45-degree field of view. 2352x1568 — 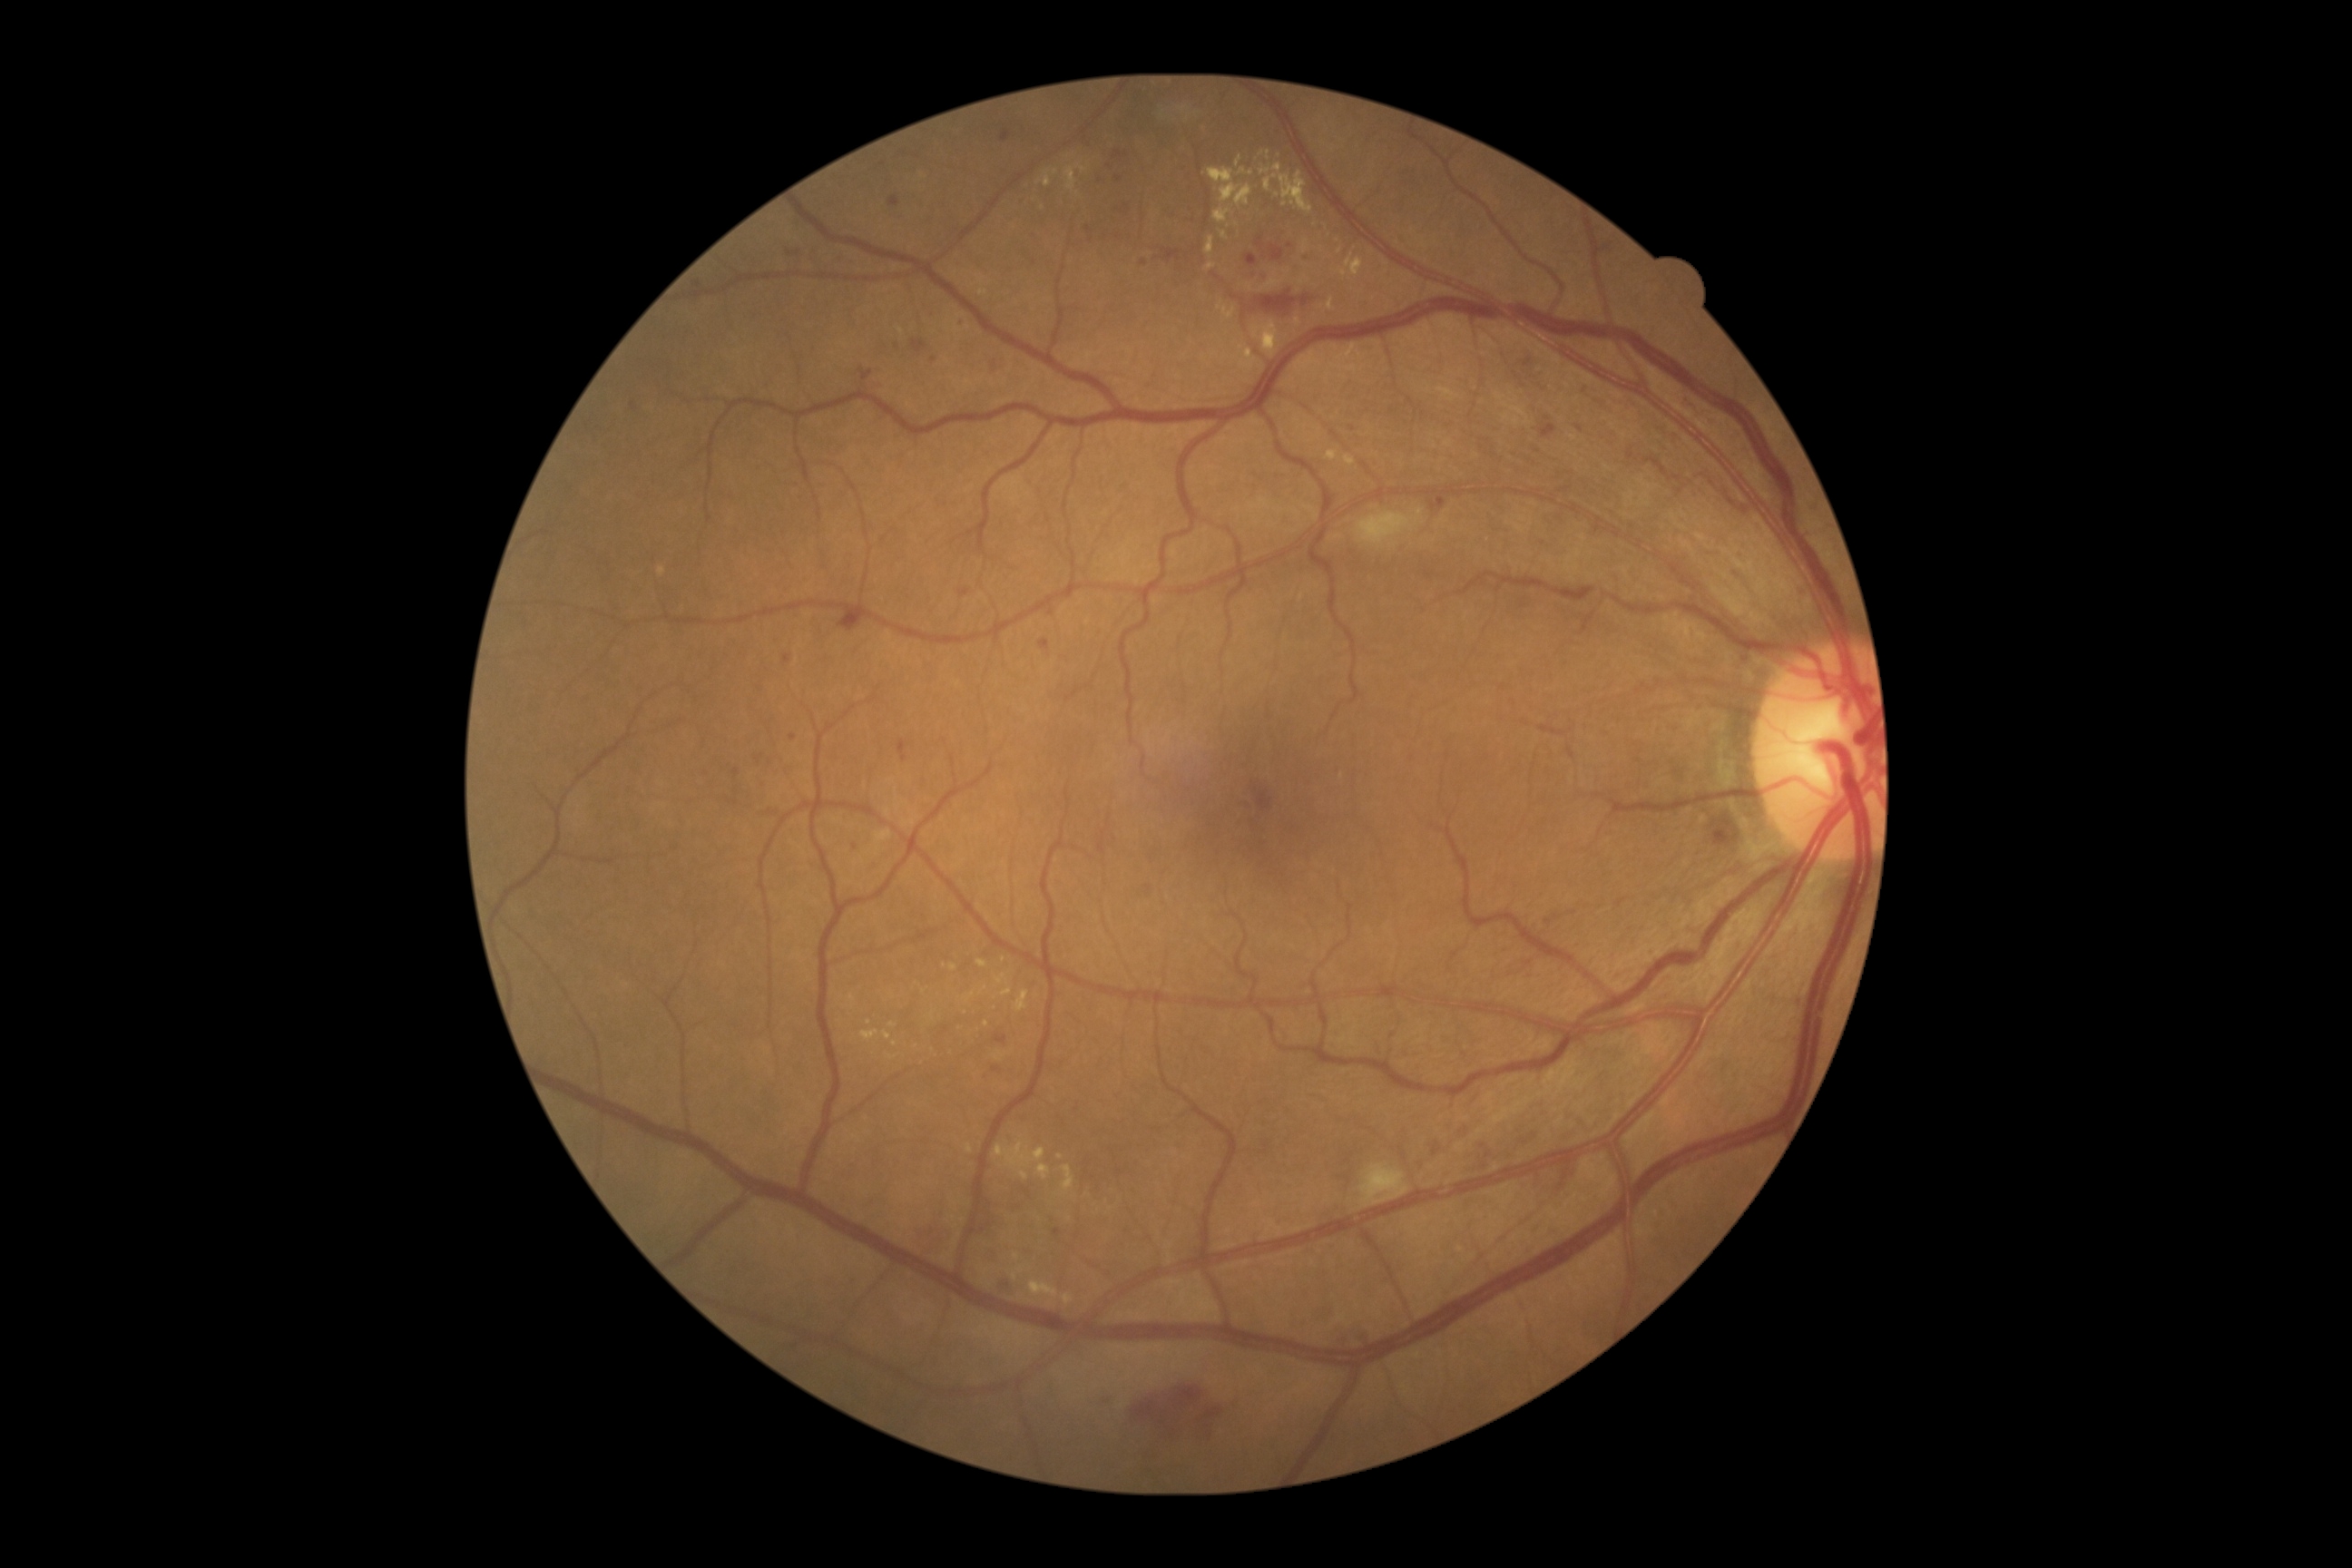
Retinopathy grade: 2
A subset of detected lesions:
- microaneurysms (subset): 1271, 246, 1284, 262 | 1246, 255, 1259, 268 | 959, 589, 970, 598 | 956, 317, 966, 328 | 1104, 164, 1115, 172 | 995, 1035, 1008, 1044 | 1257, 239, 1262, 248
- Small microaneurysms near (1102, 178) | (788, 659) | (933, 361) | (737, 773) | (799, 253) | (856, 847)
- hard exudates (subset): 1260, 170, 1271, 175 | 995, 1142, 1046, 1170 | 888, 1055, 897, 1061 | 861, 1030, 879, 1041 | 1240, 168, 1253, 177 | 1063, 1293, 1073, 1306 | 1333, 253, 1364, 279 | 1273, 164, 1282, 173 | 1213, 208, 1231, 224 | 1244, 357, 1259, 366 | 1348, 335, 1358, 358 | 1302, 240, 1308, 255 | 1344, 456, 1355, 466 | 1037, 170, 1059, 188
- Small hard exudates near (1278, 195) | (1341, 252) | (986, 988) | (869, 1023)